Infant wide-field fundus photograph; 100° field of view (Phoenix ICON)
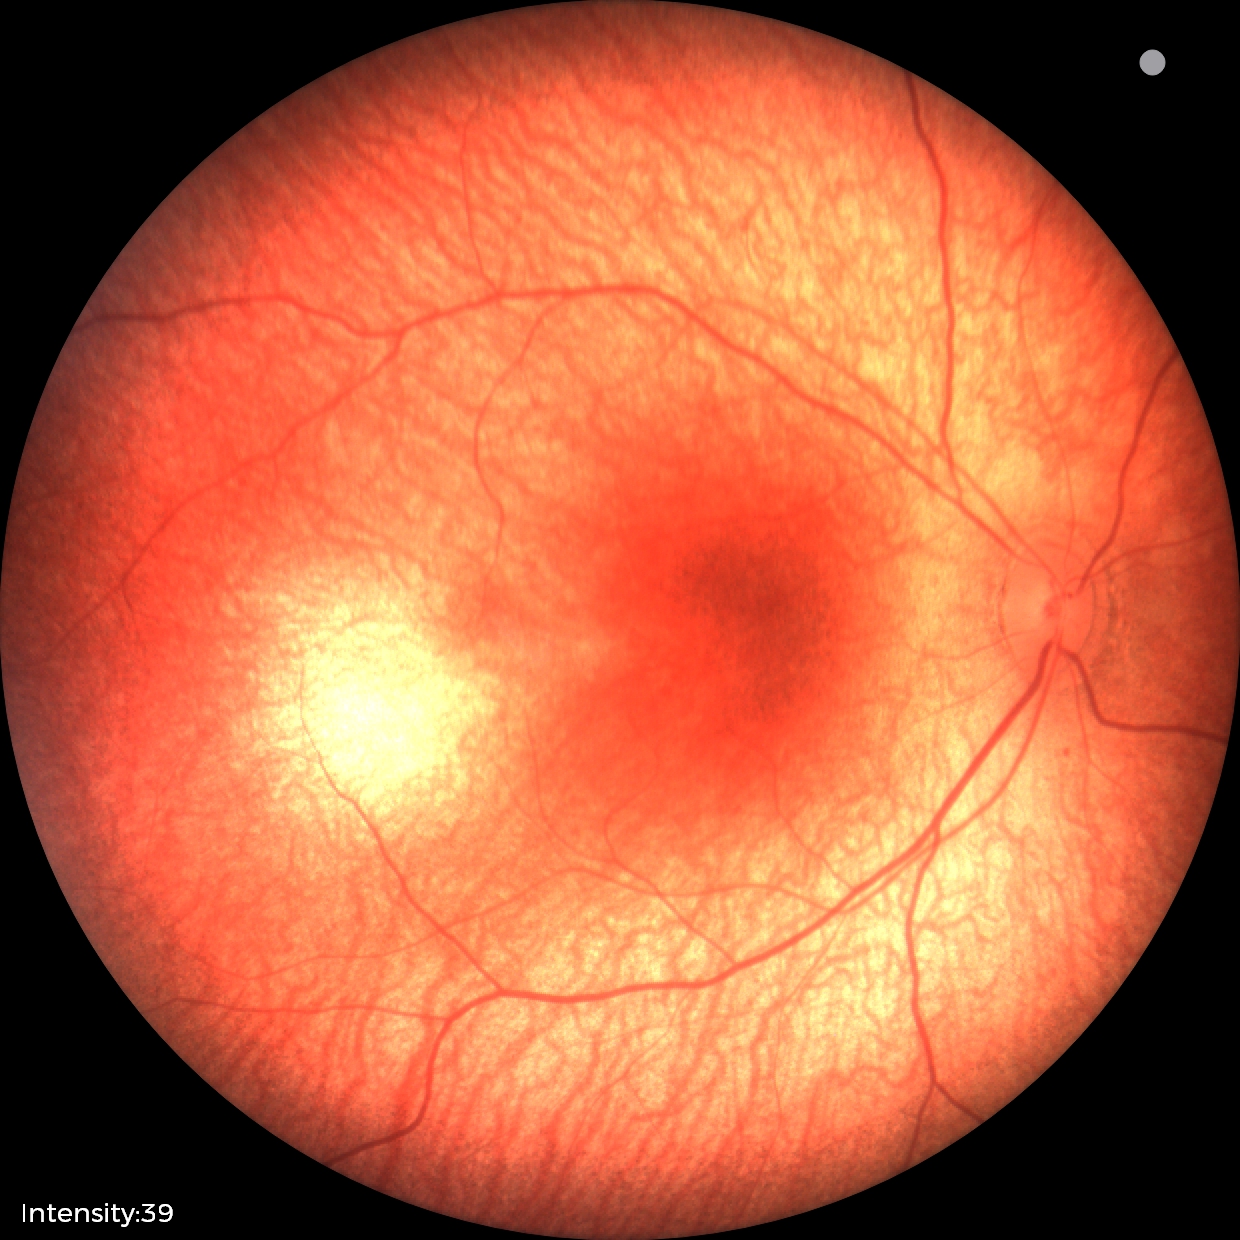

No retinal pathology identified on screening.